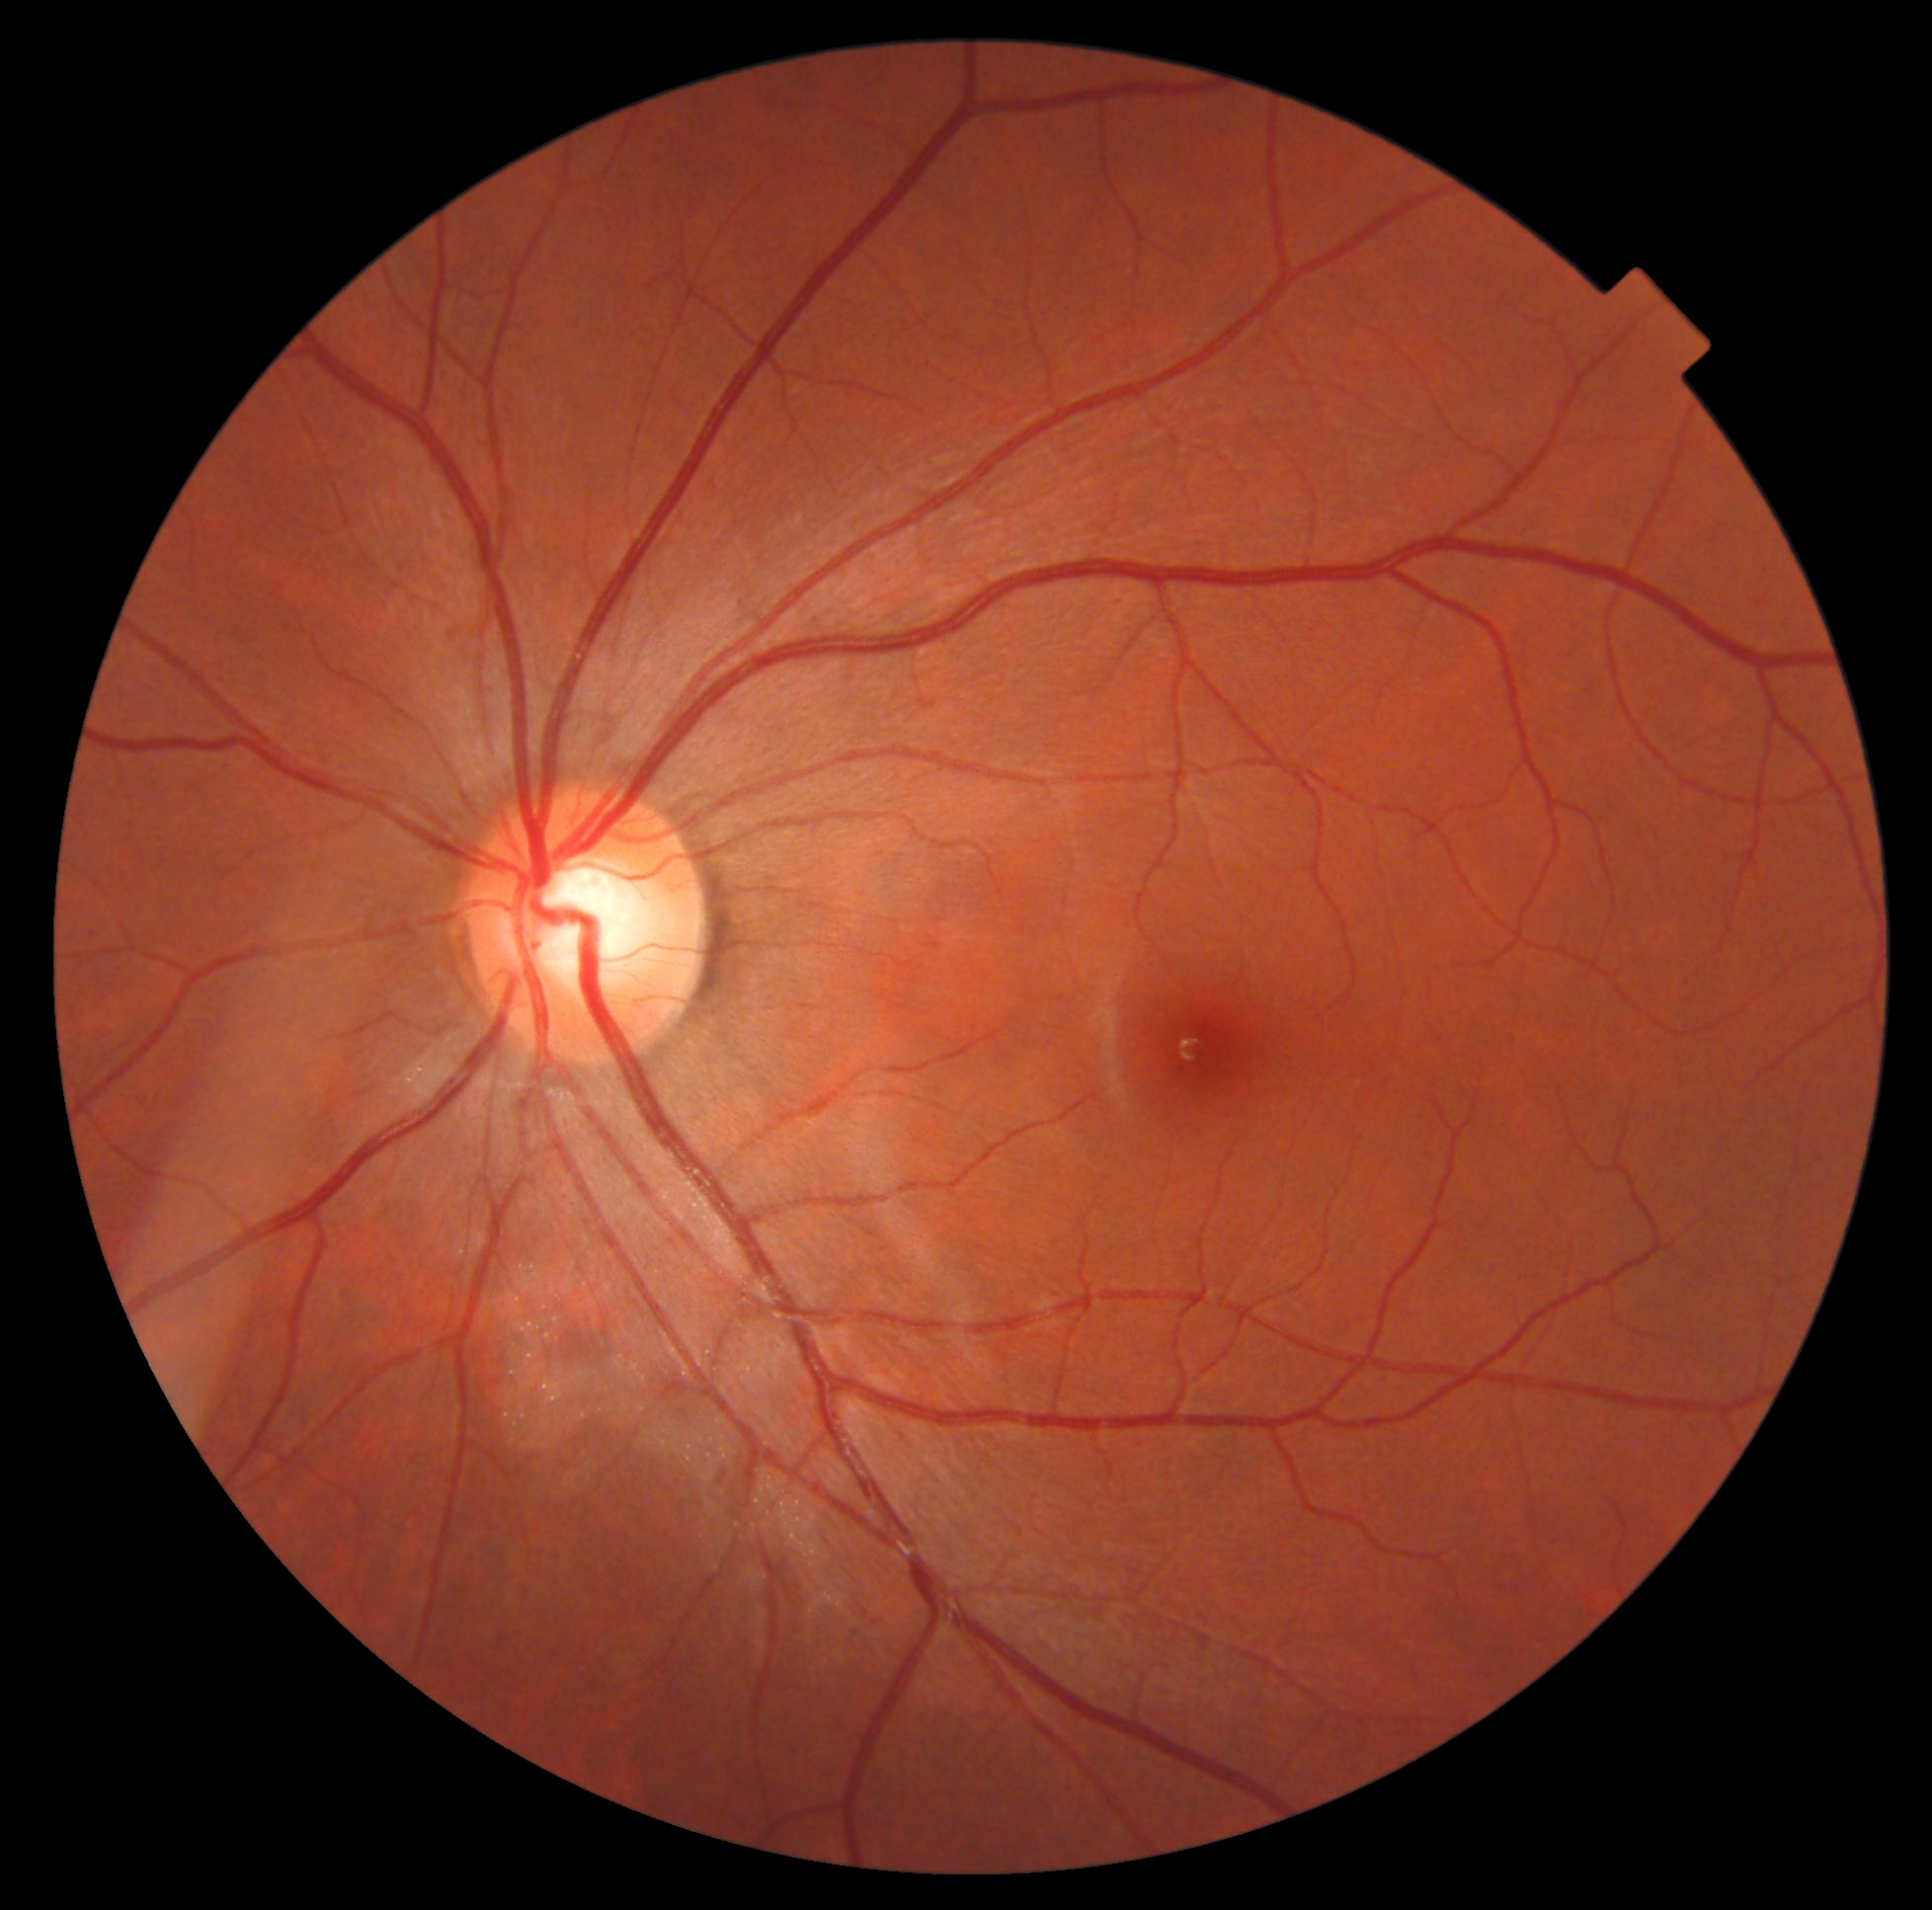
Diabetic retinopathy: no apparent diabetic retinopathy (grade 0).